Camera: Natus RetCam Envision (130° FOV). Wide-field fundus photograph from neonatal ROP screening — 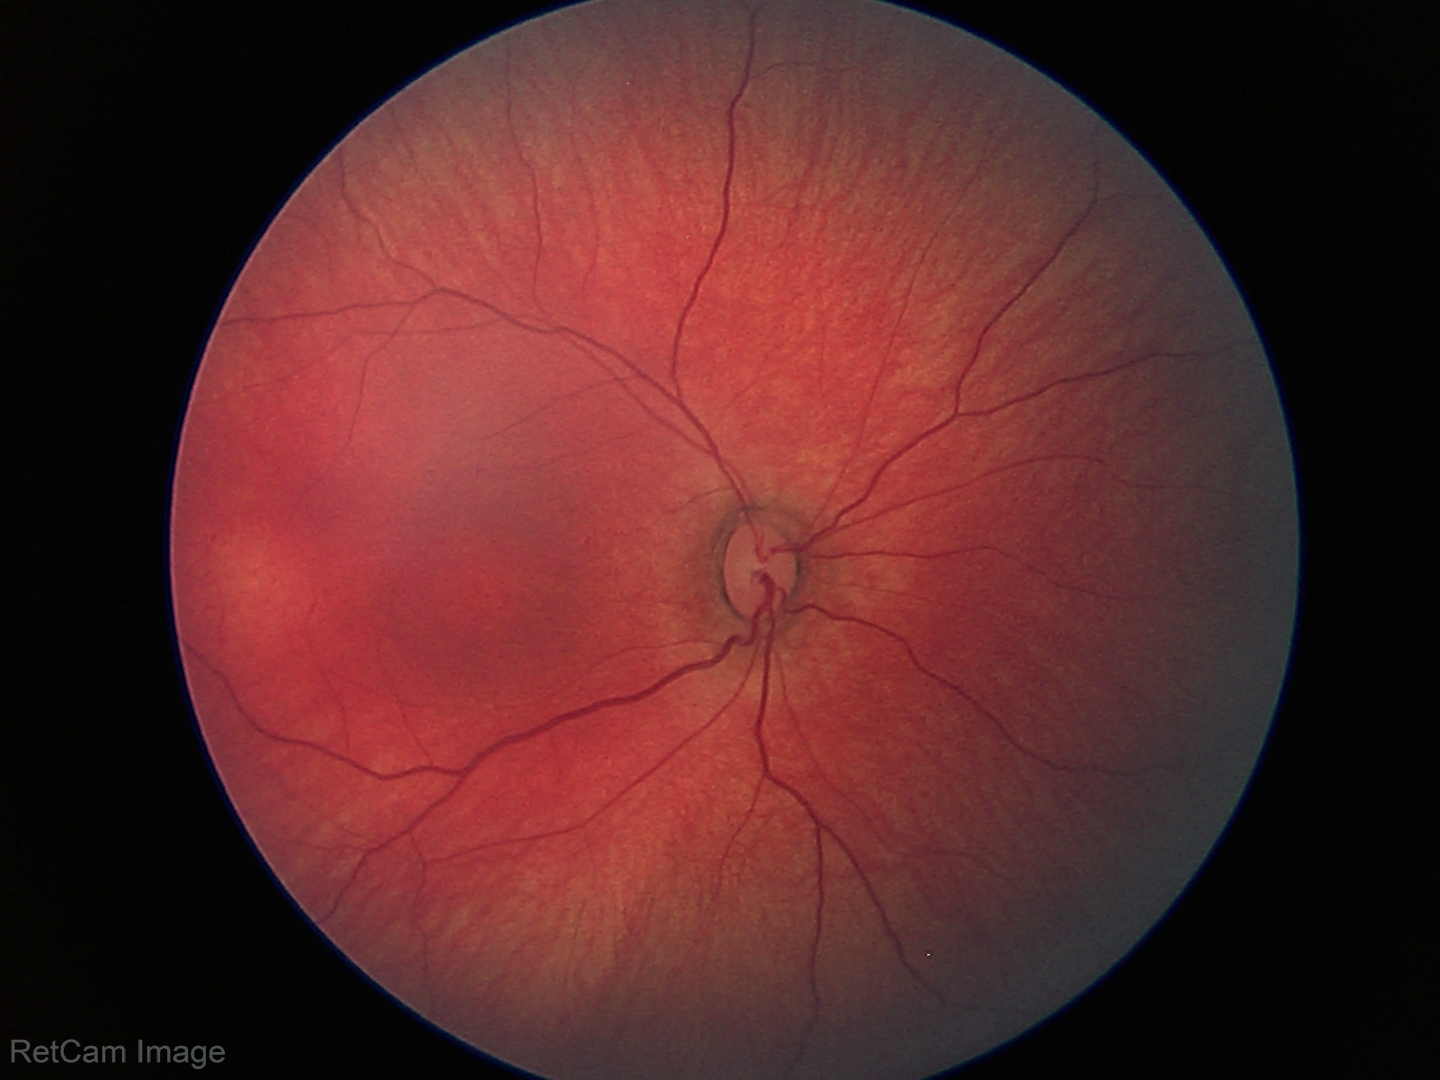

Finding = physiological